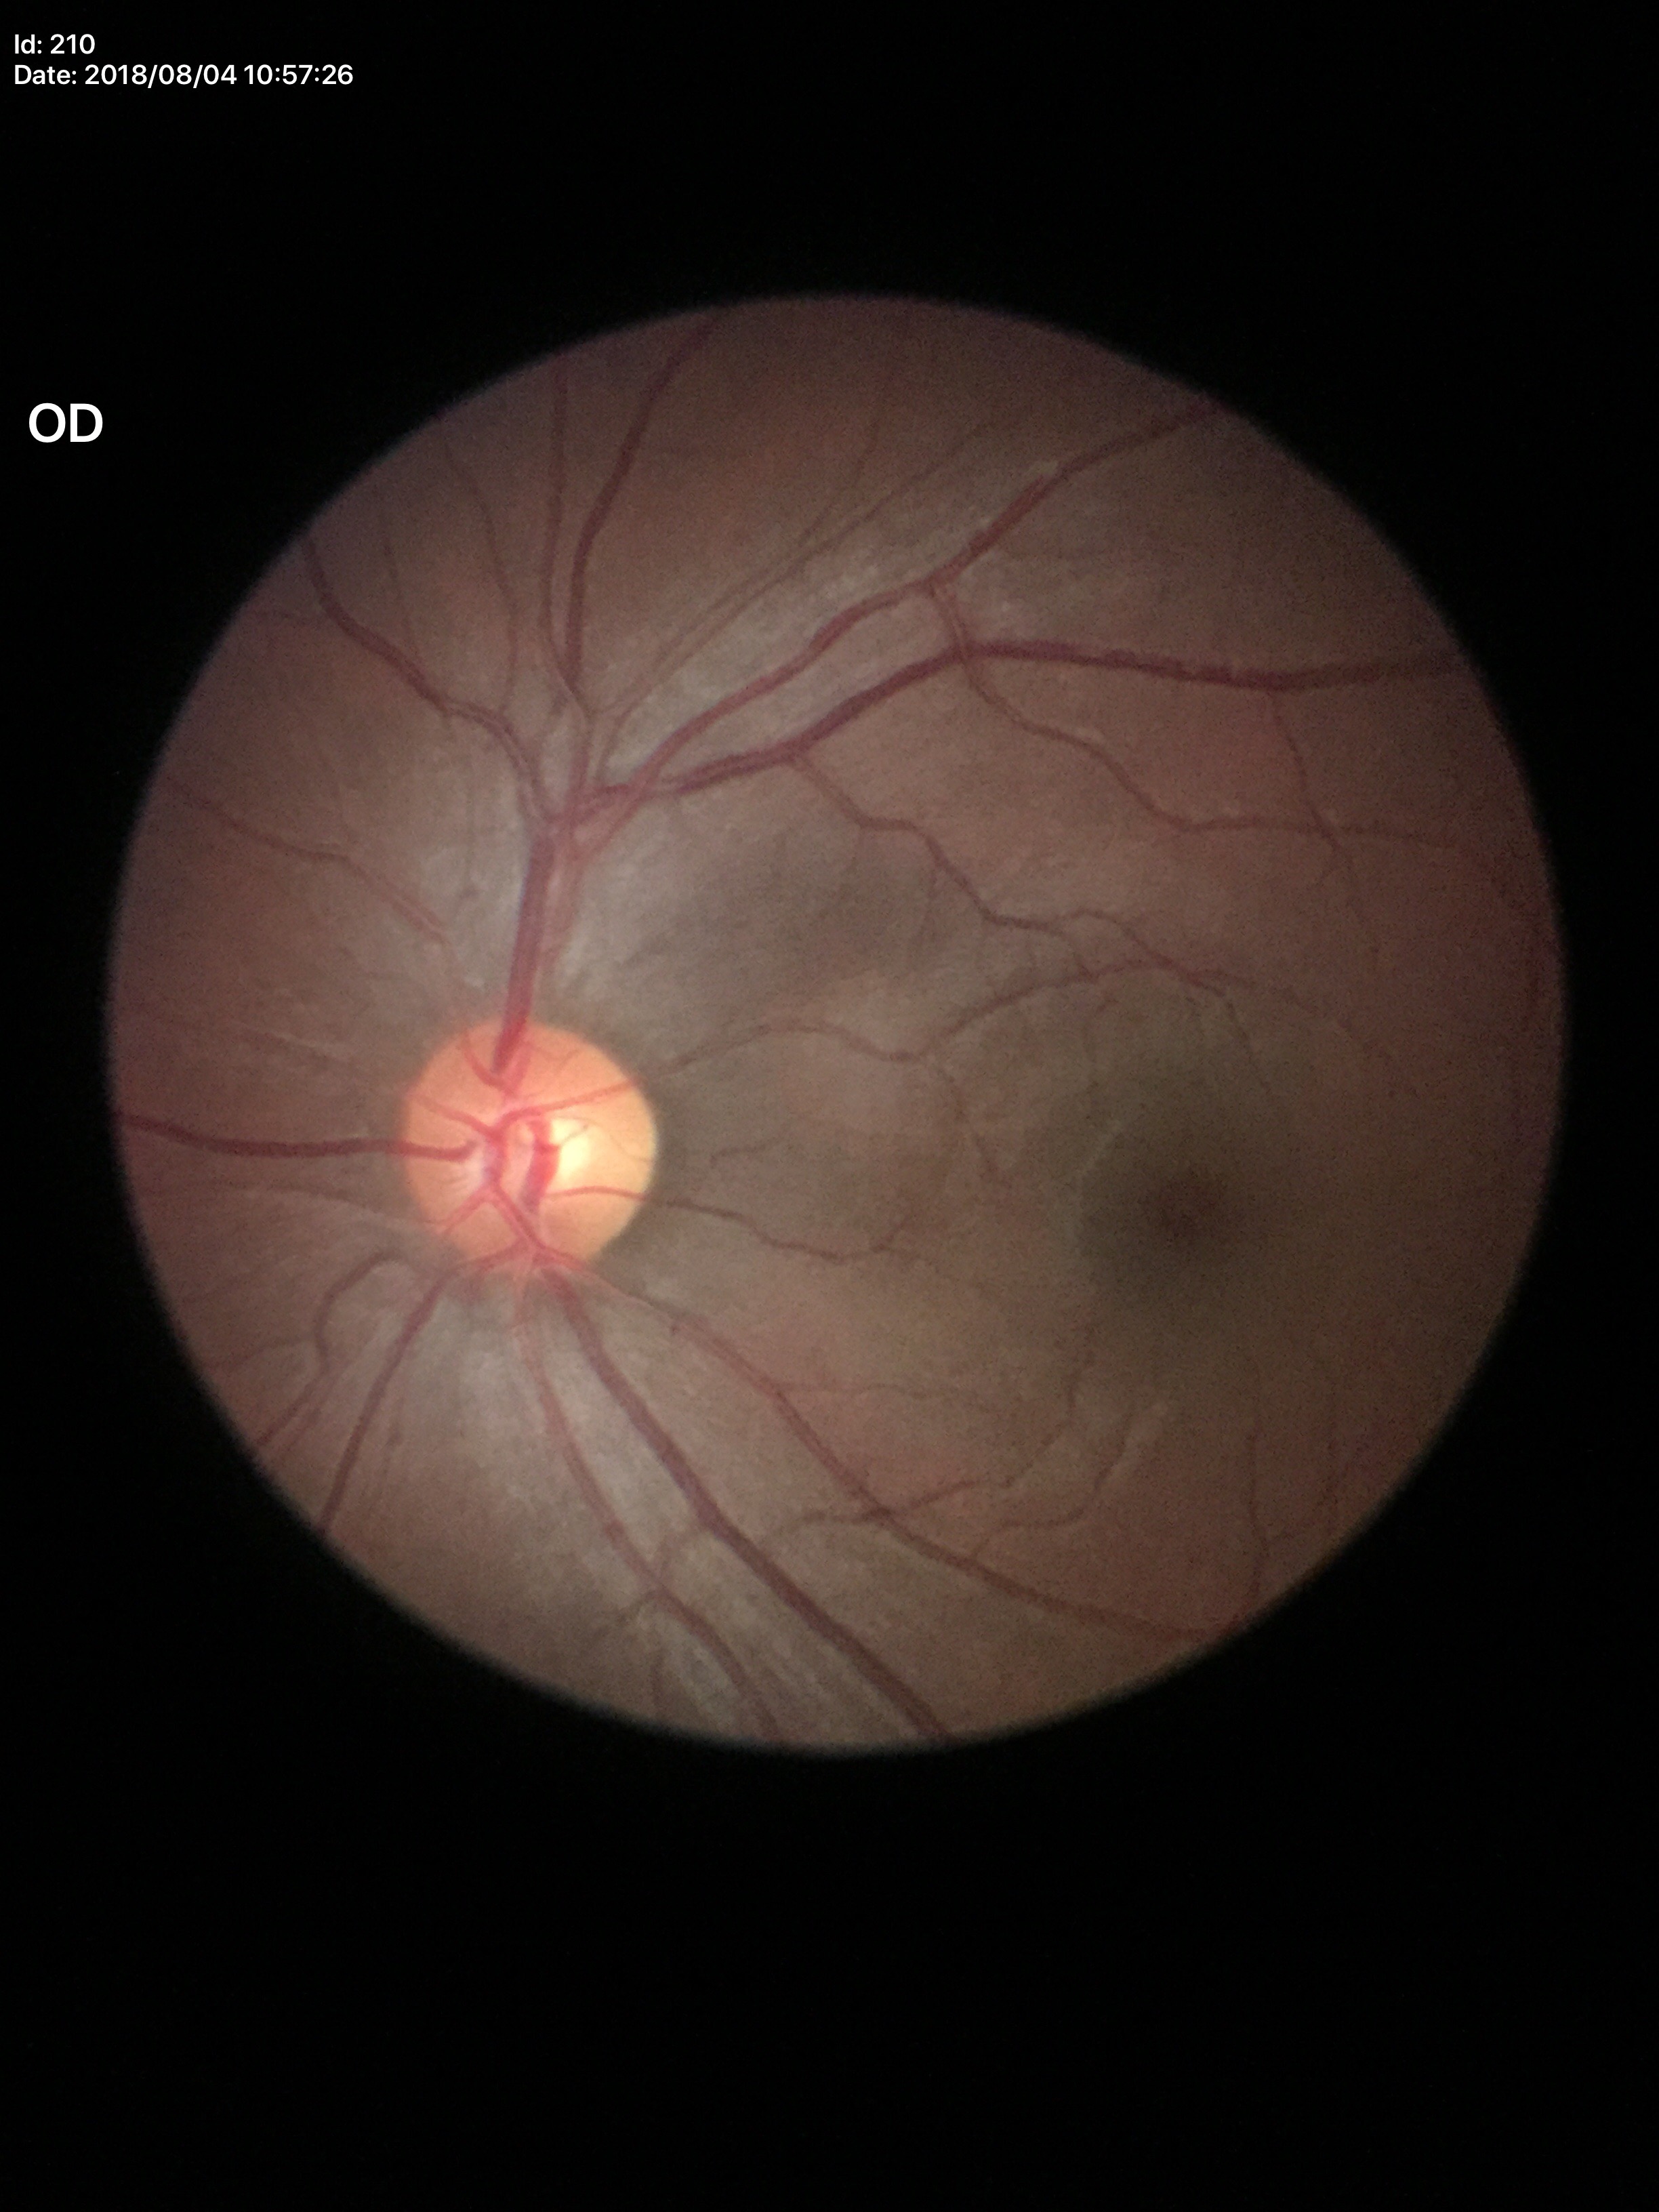
Vertical CDR (VCDR) of 0.50.
Glaucoma impression: negative.
Horizontal CDR (HCDR) of 0.55.